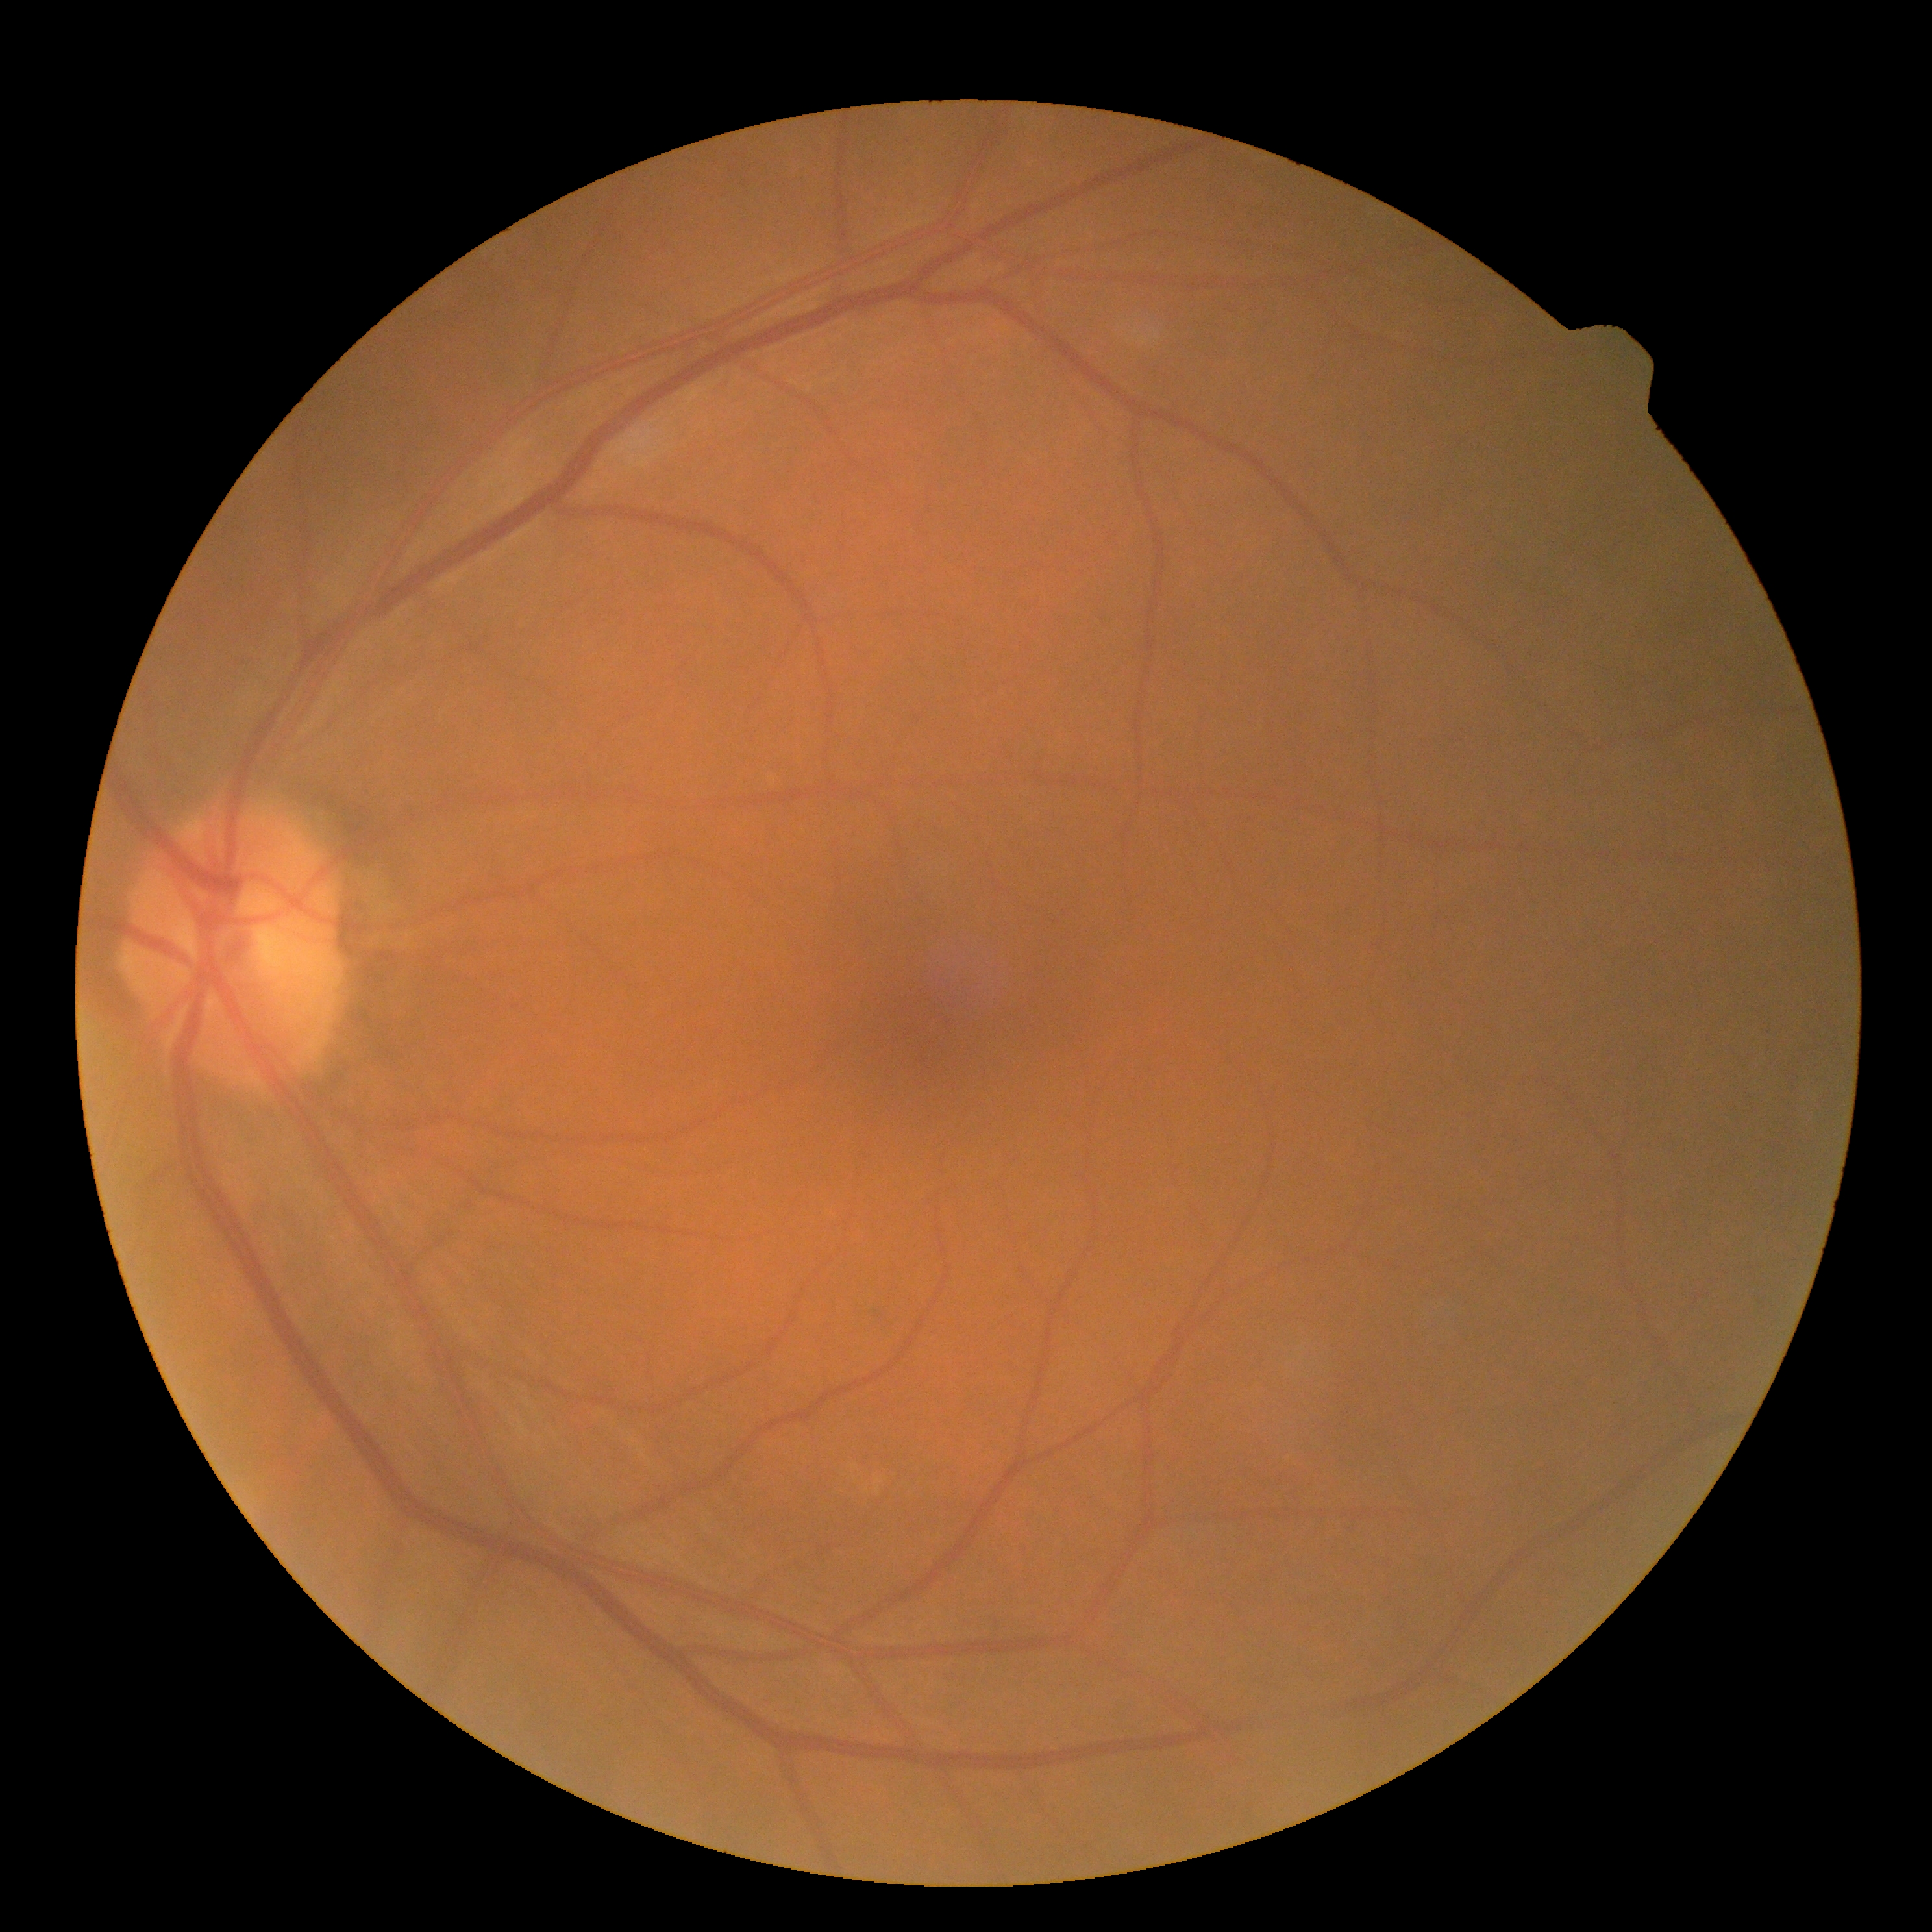 {"dr_impression": "no DR findings", "dr_grade": "grade 0 (no apparent retinopathy)"}